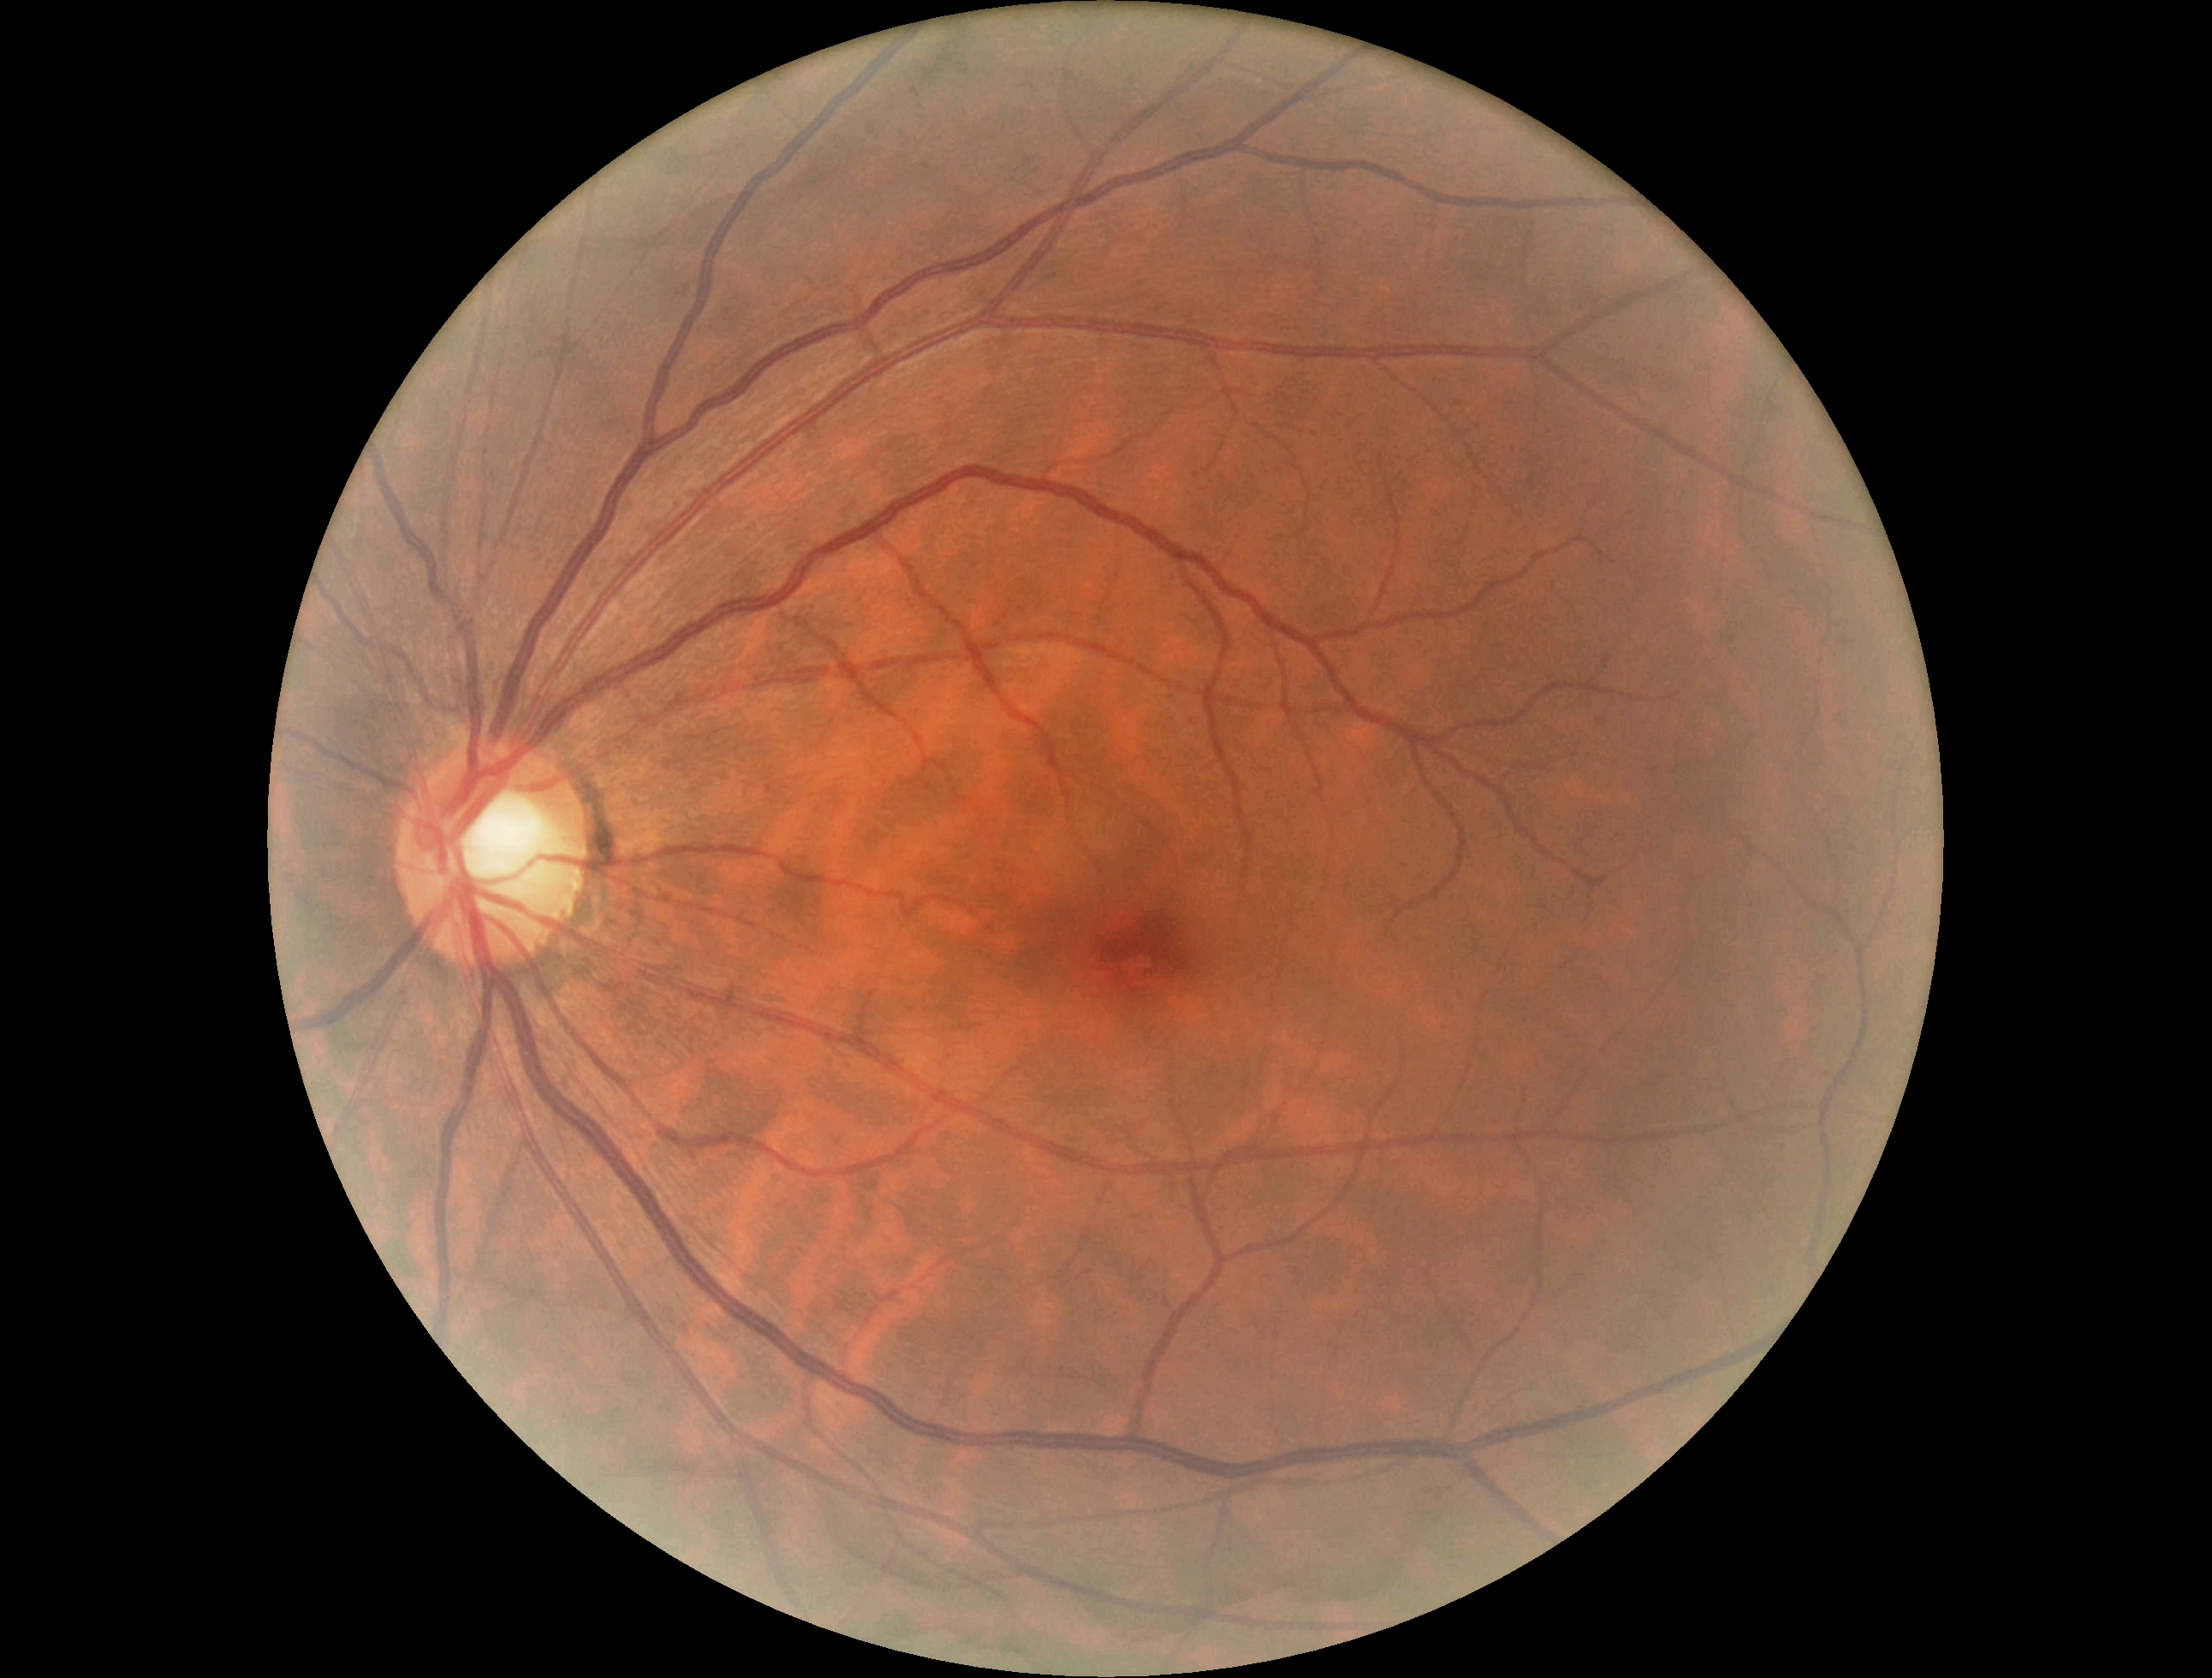

Diabetic retinopathy: grade 0 (no apparent retinopathy).